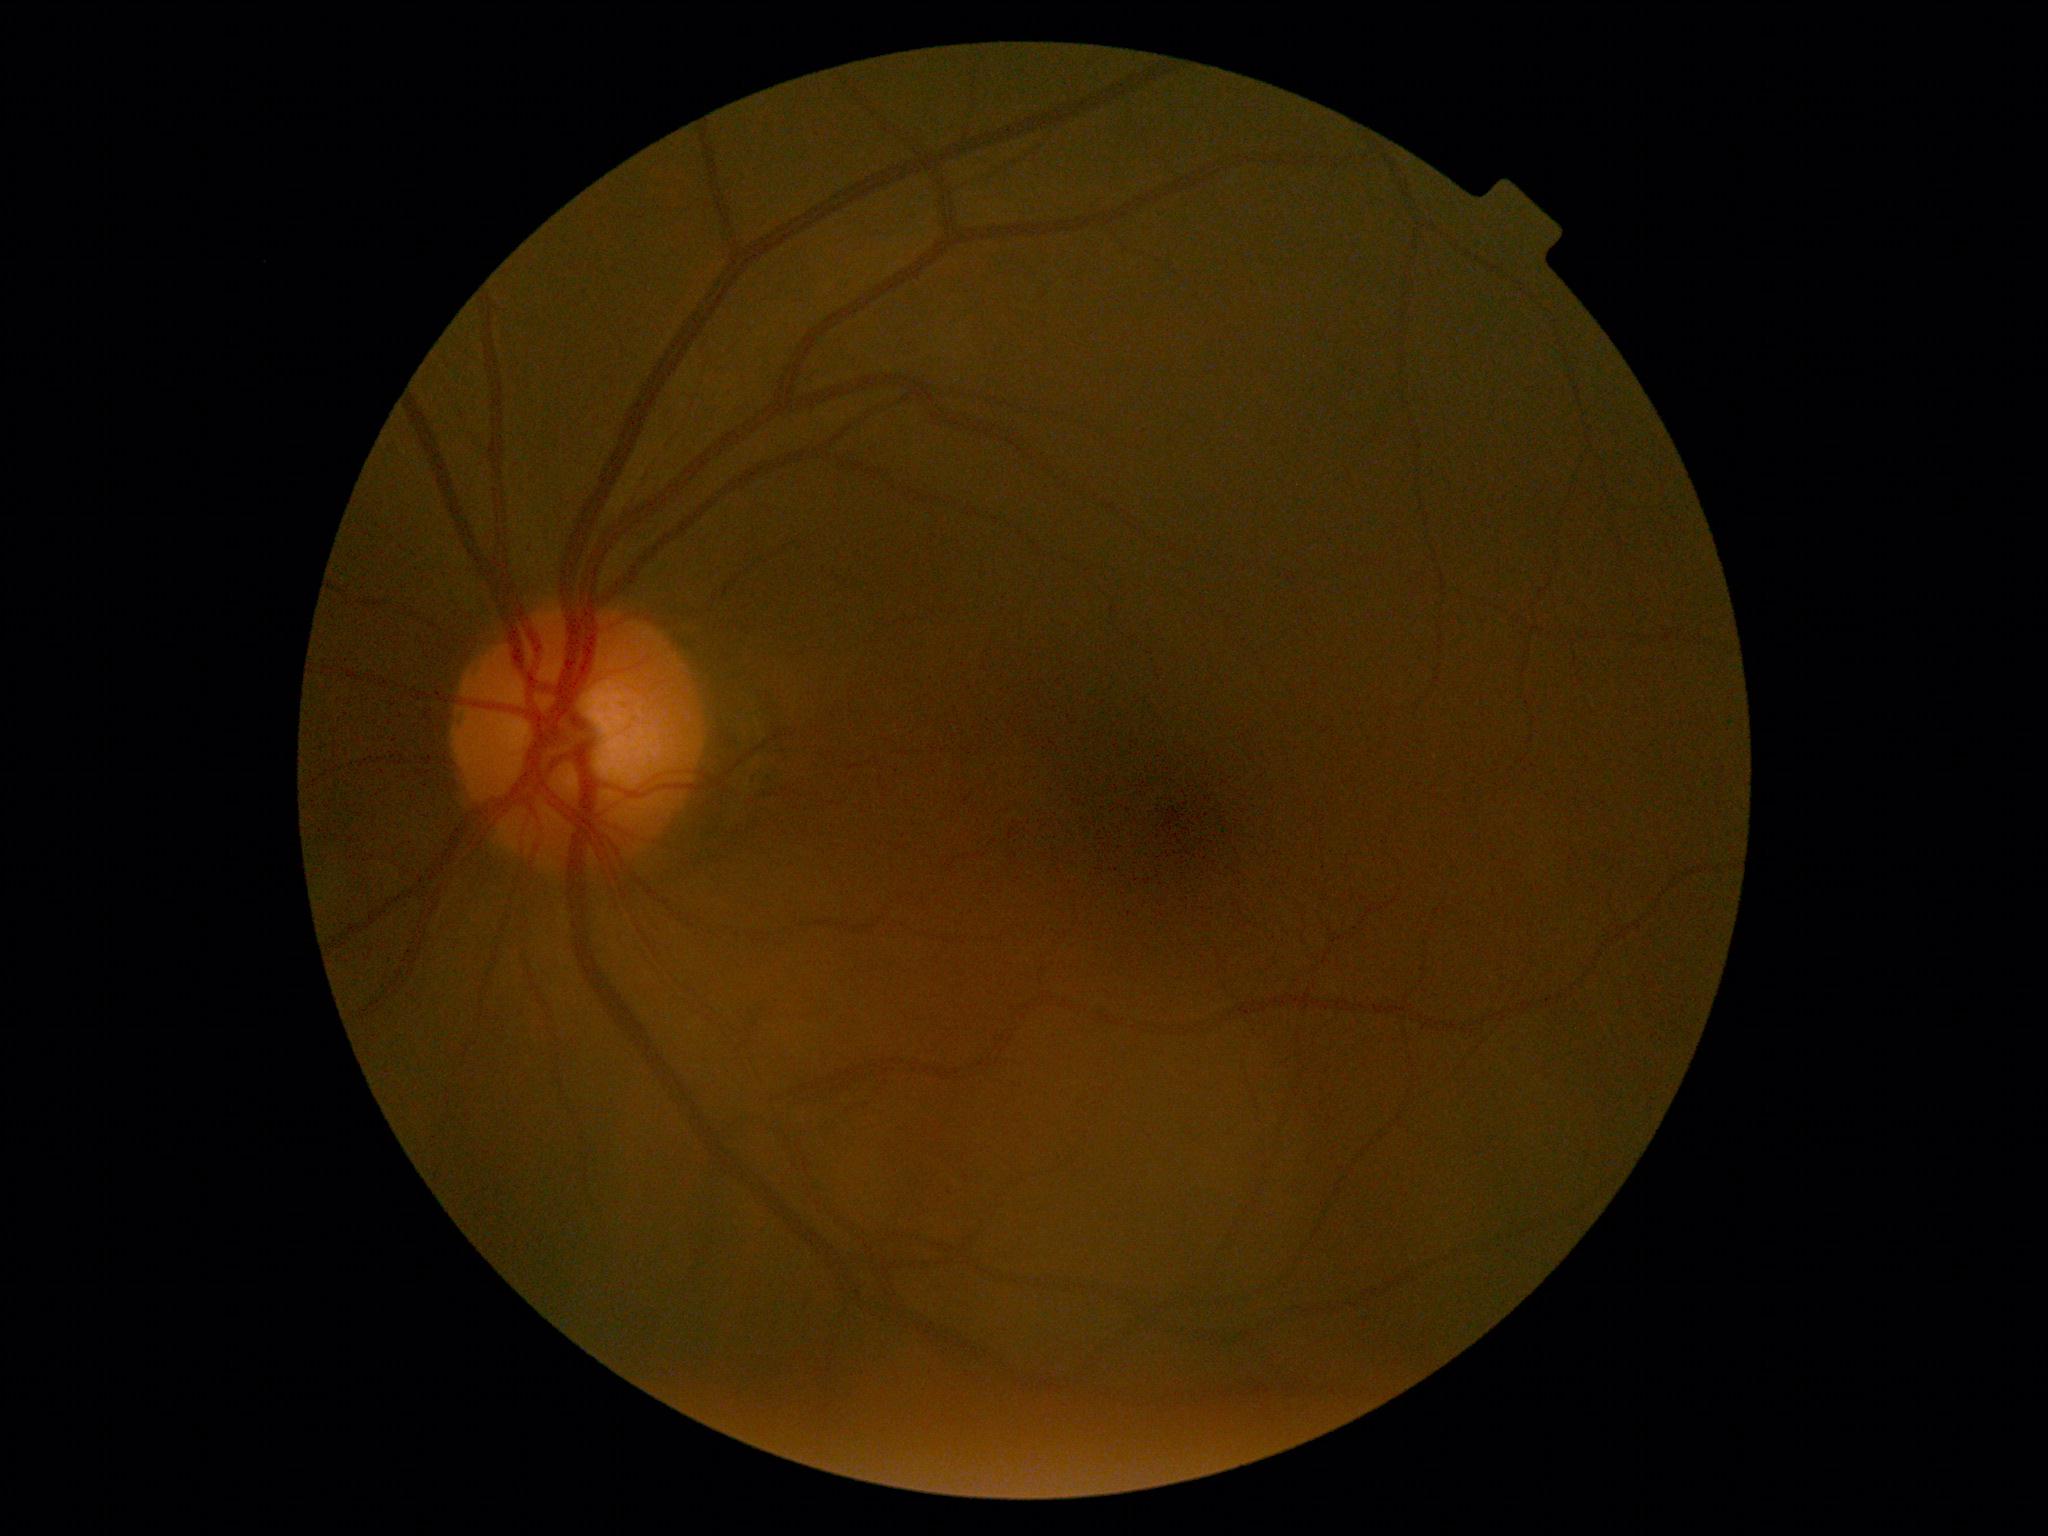
DR: grade 0 — no visible signs of diabetic retinopathy.